Wide-field fundus photograph from neonatal ROP screening; Phoenix ICON, 100° FOV:
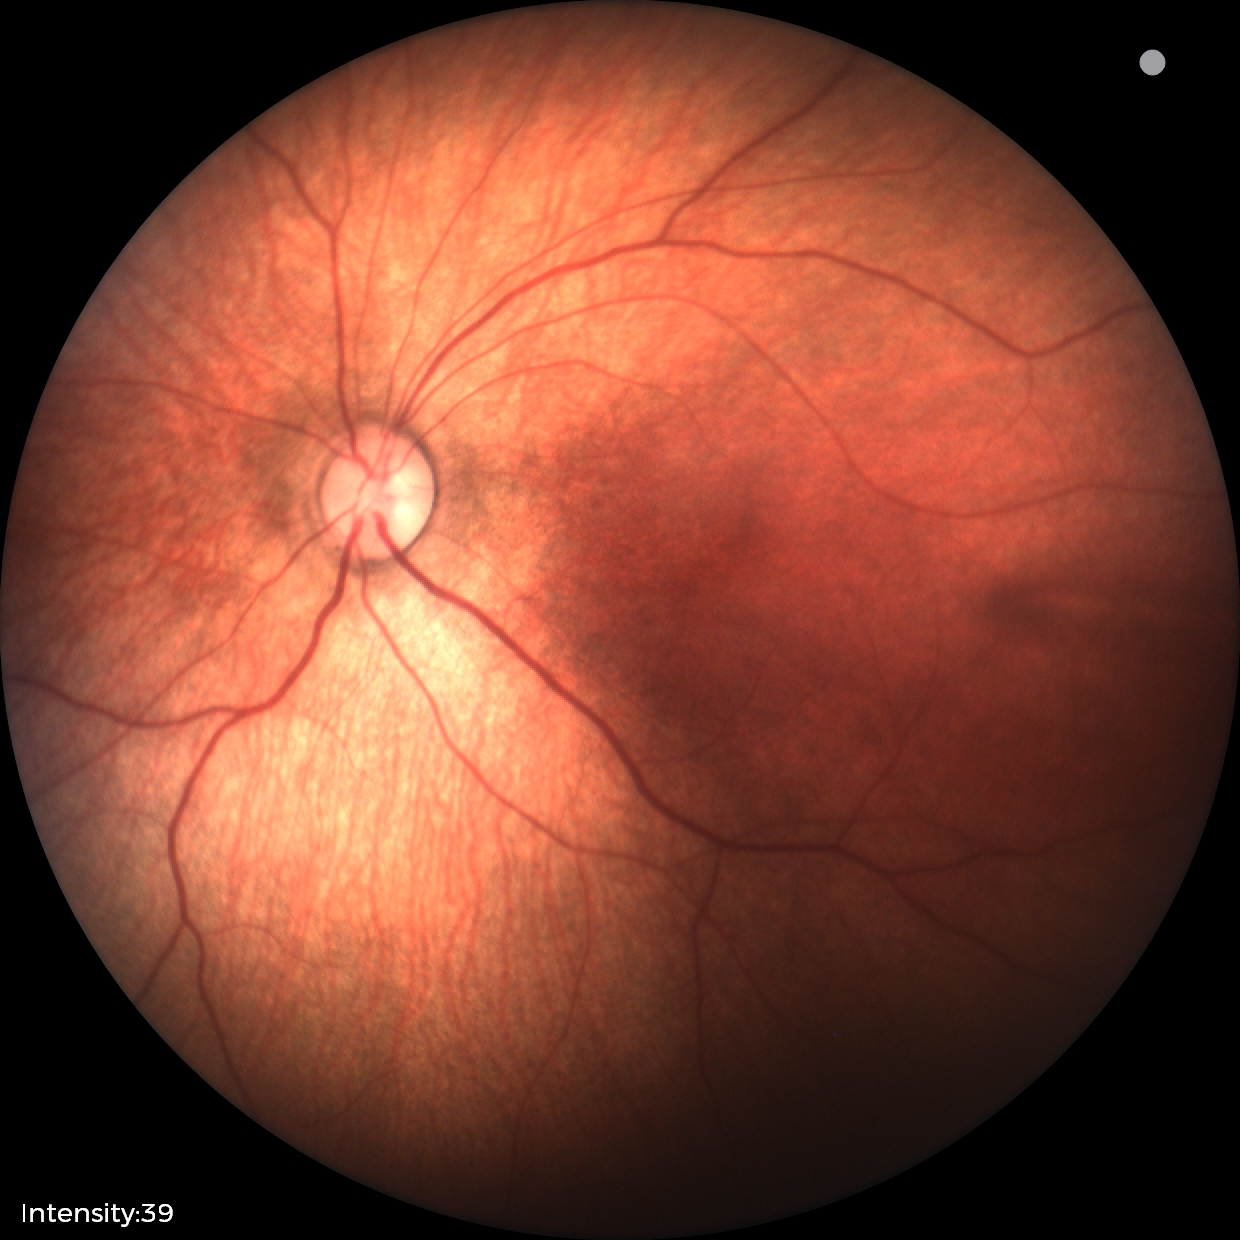 Diagnosis = normal.